Retinal fundus photograph, 1932 x 1910 pixels
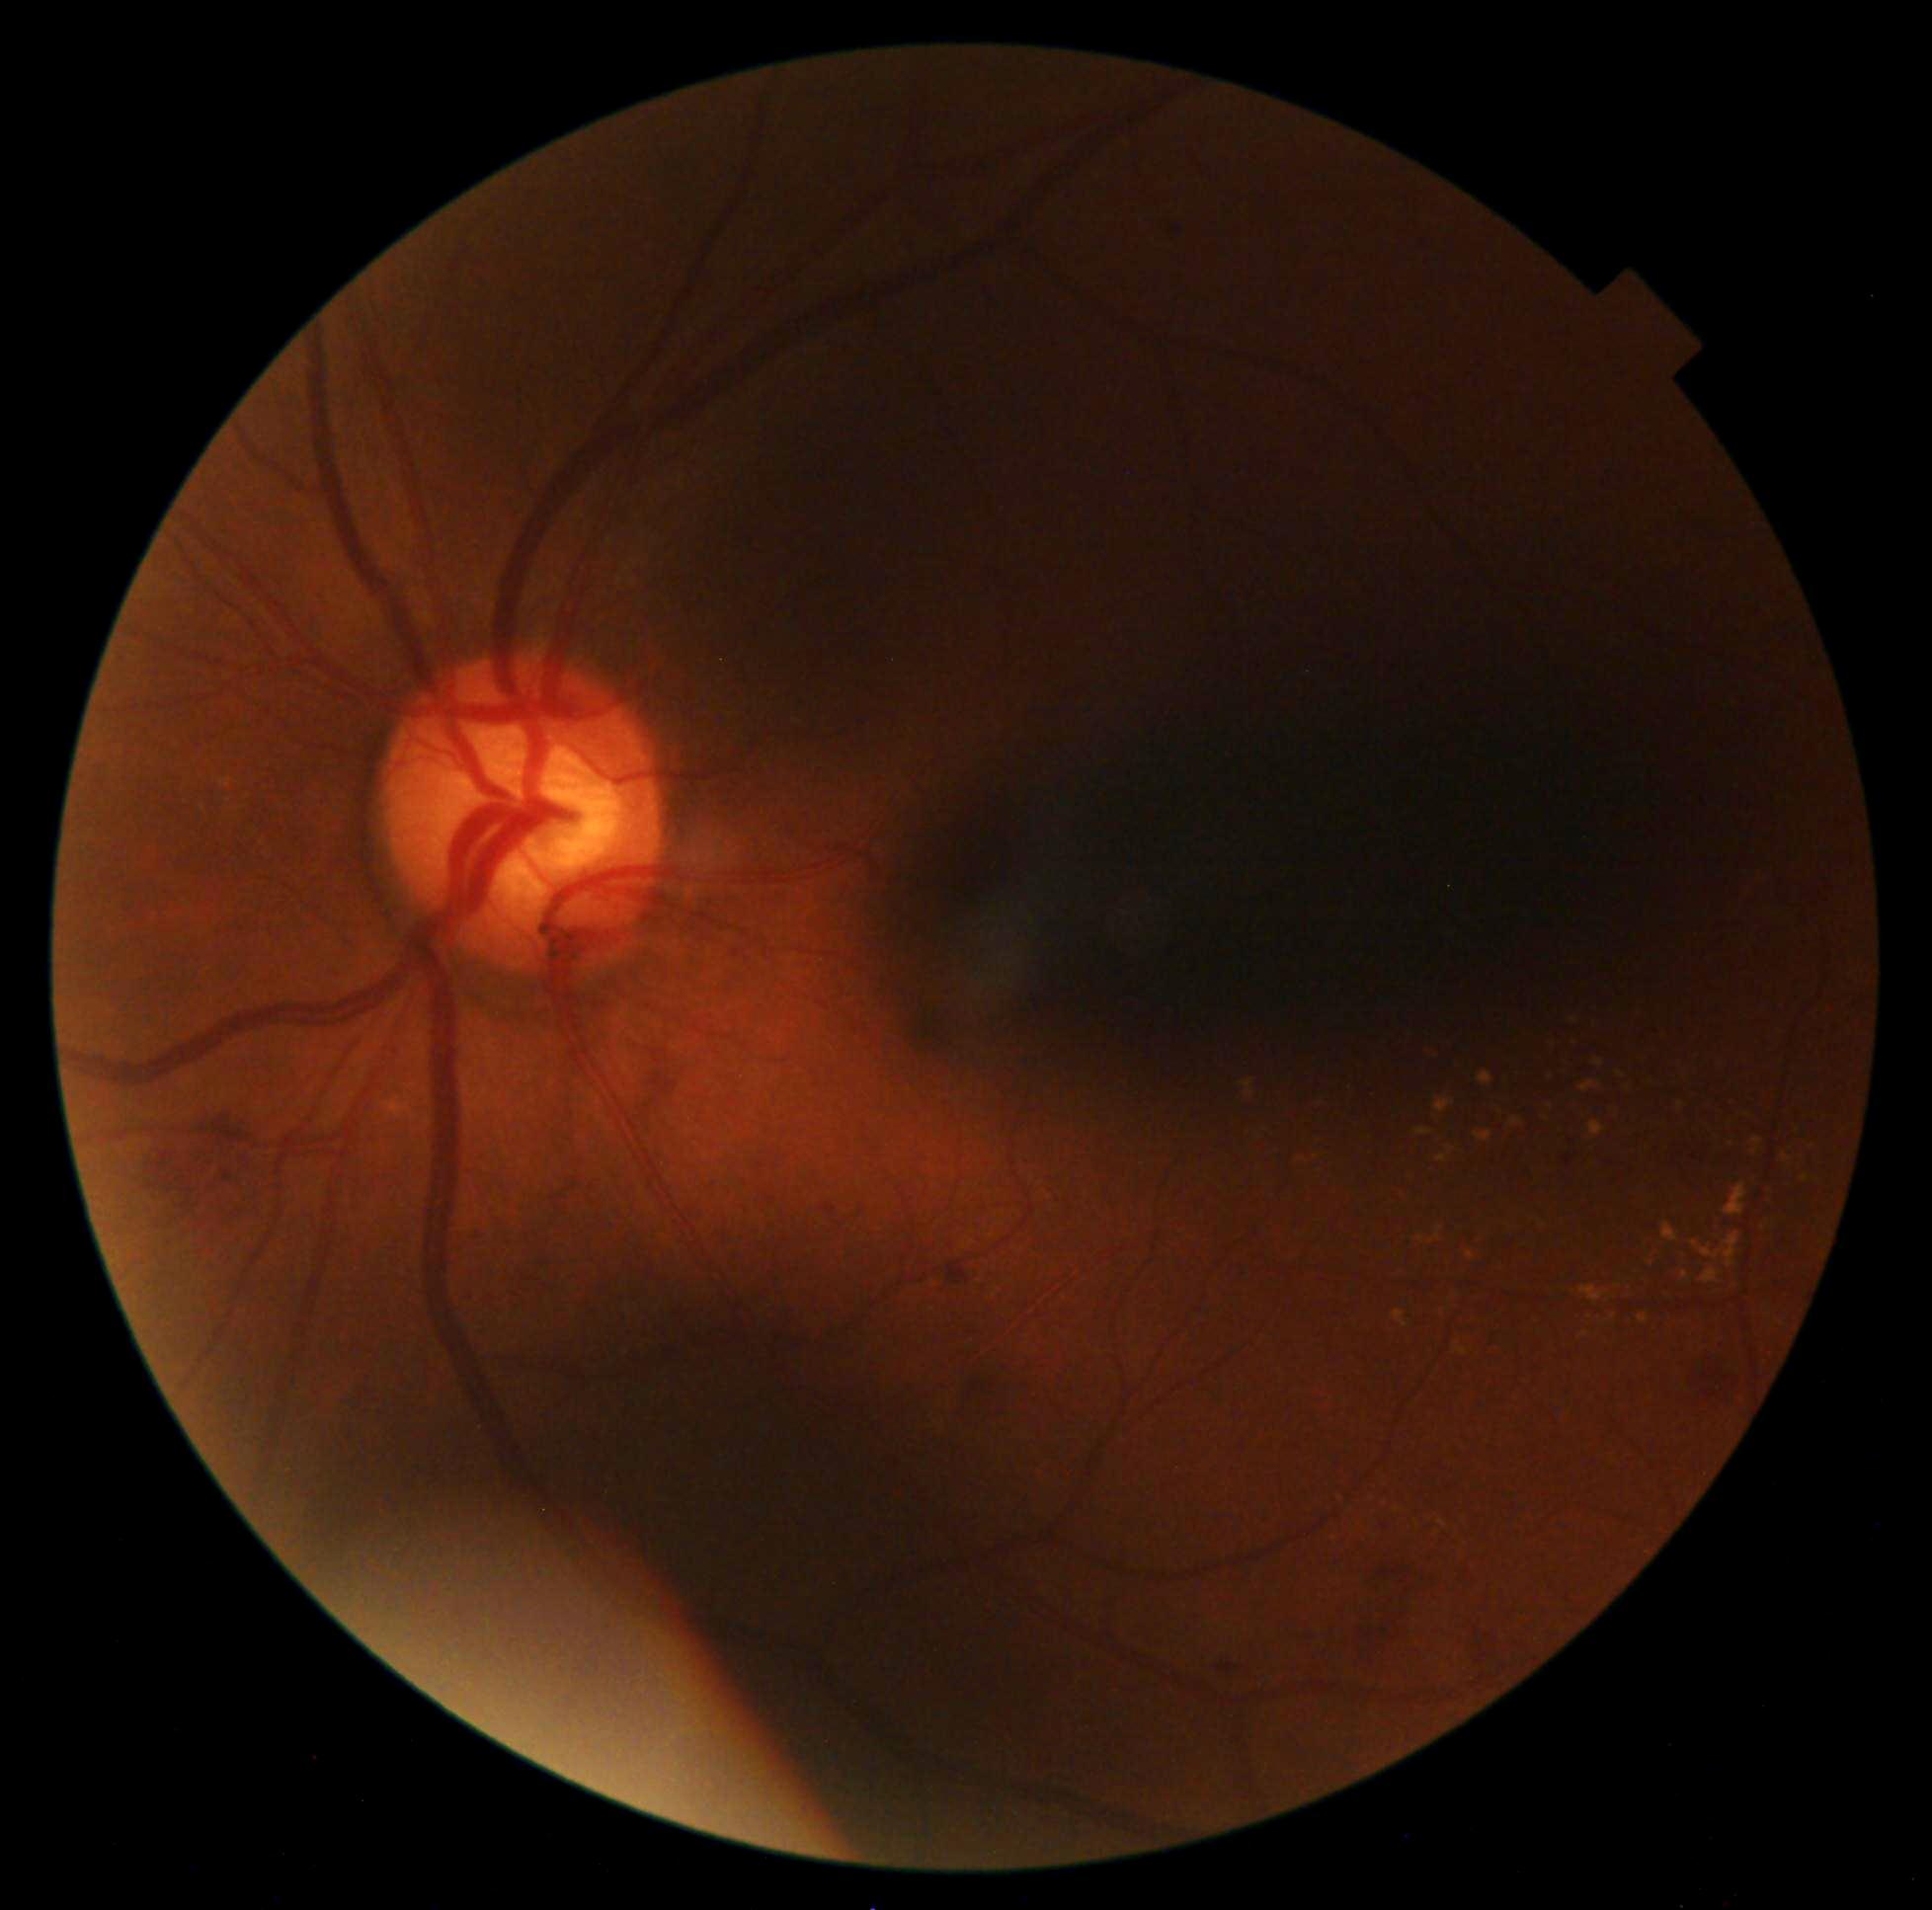

DR: 2/4.